Central posterior field; camera: Topcon TRC-50DX:
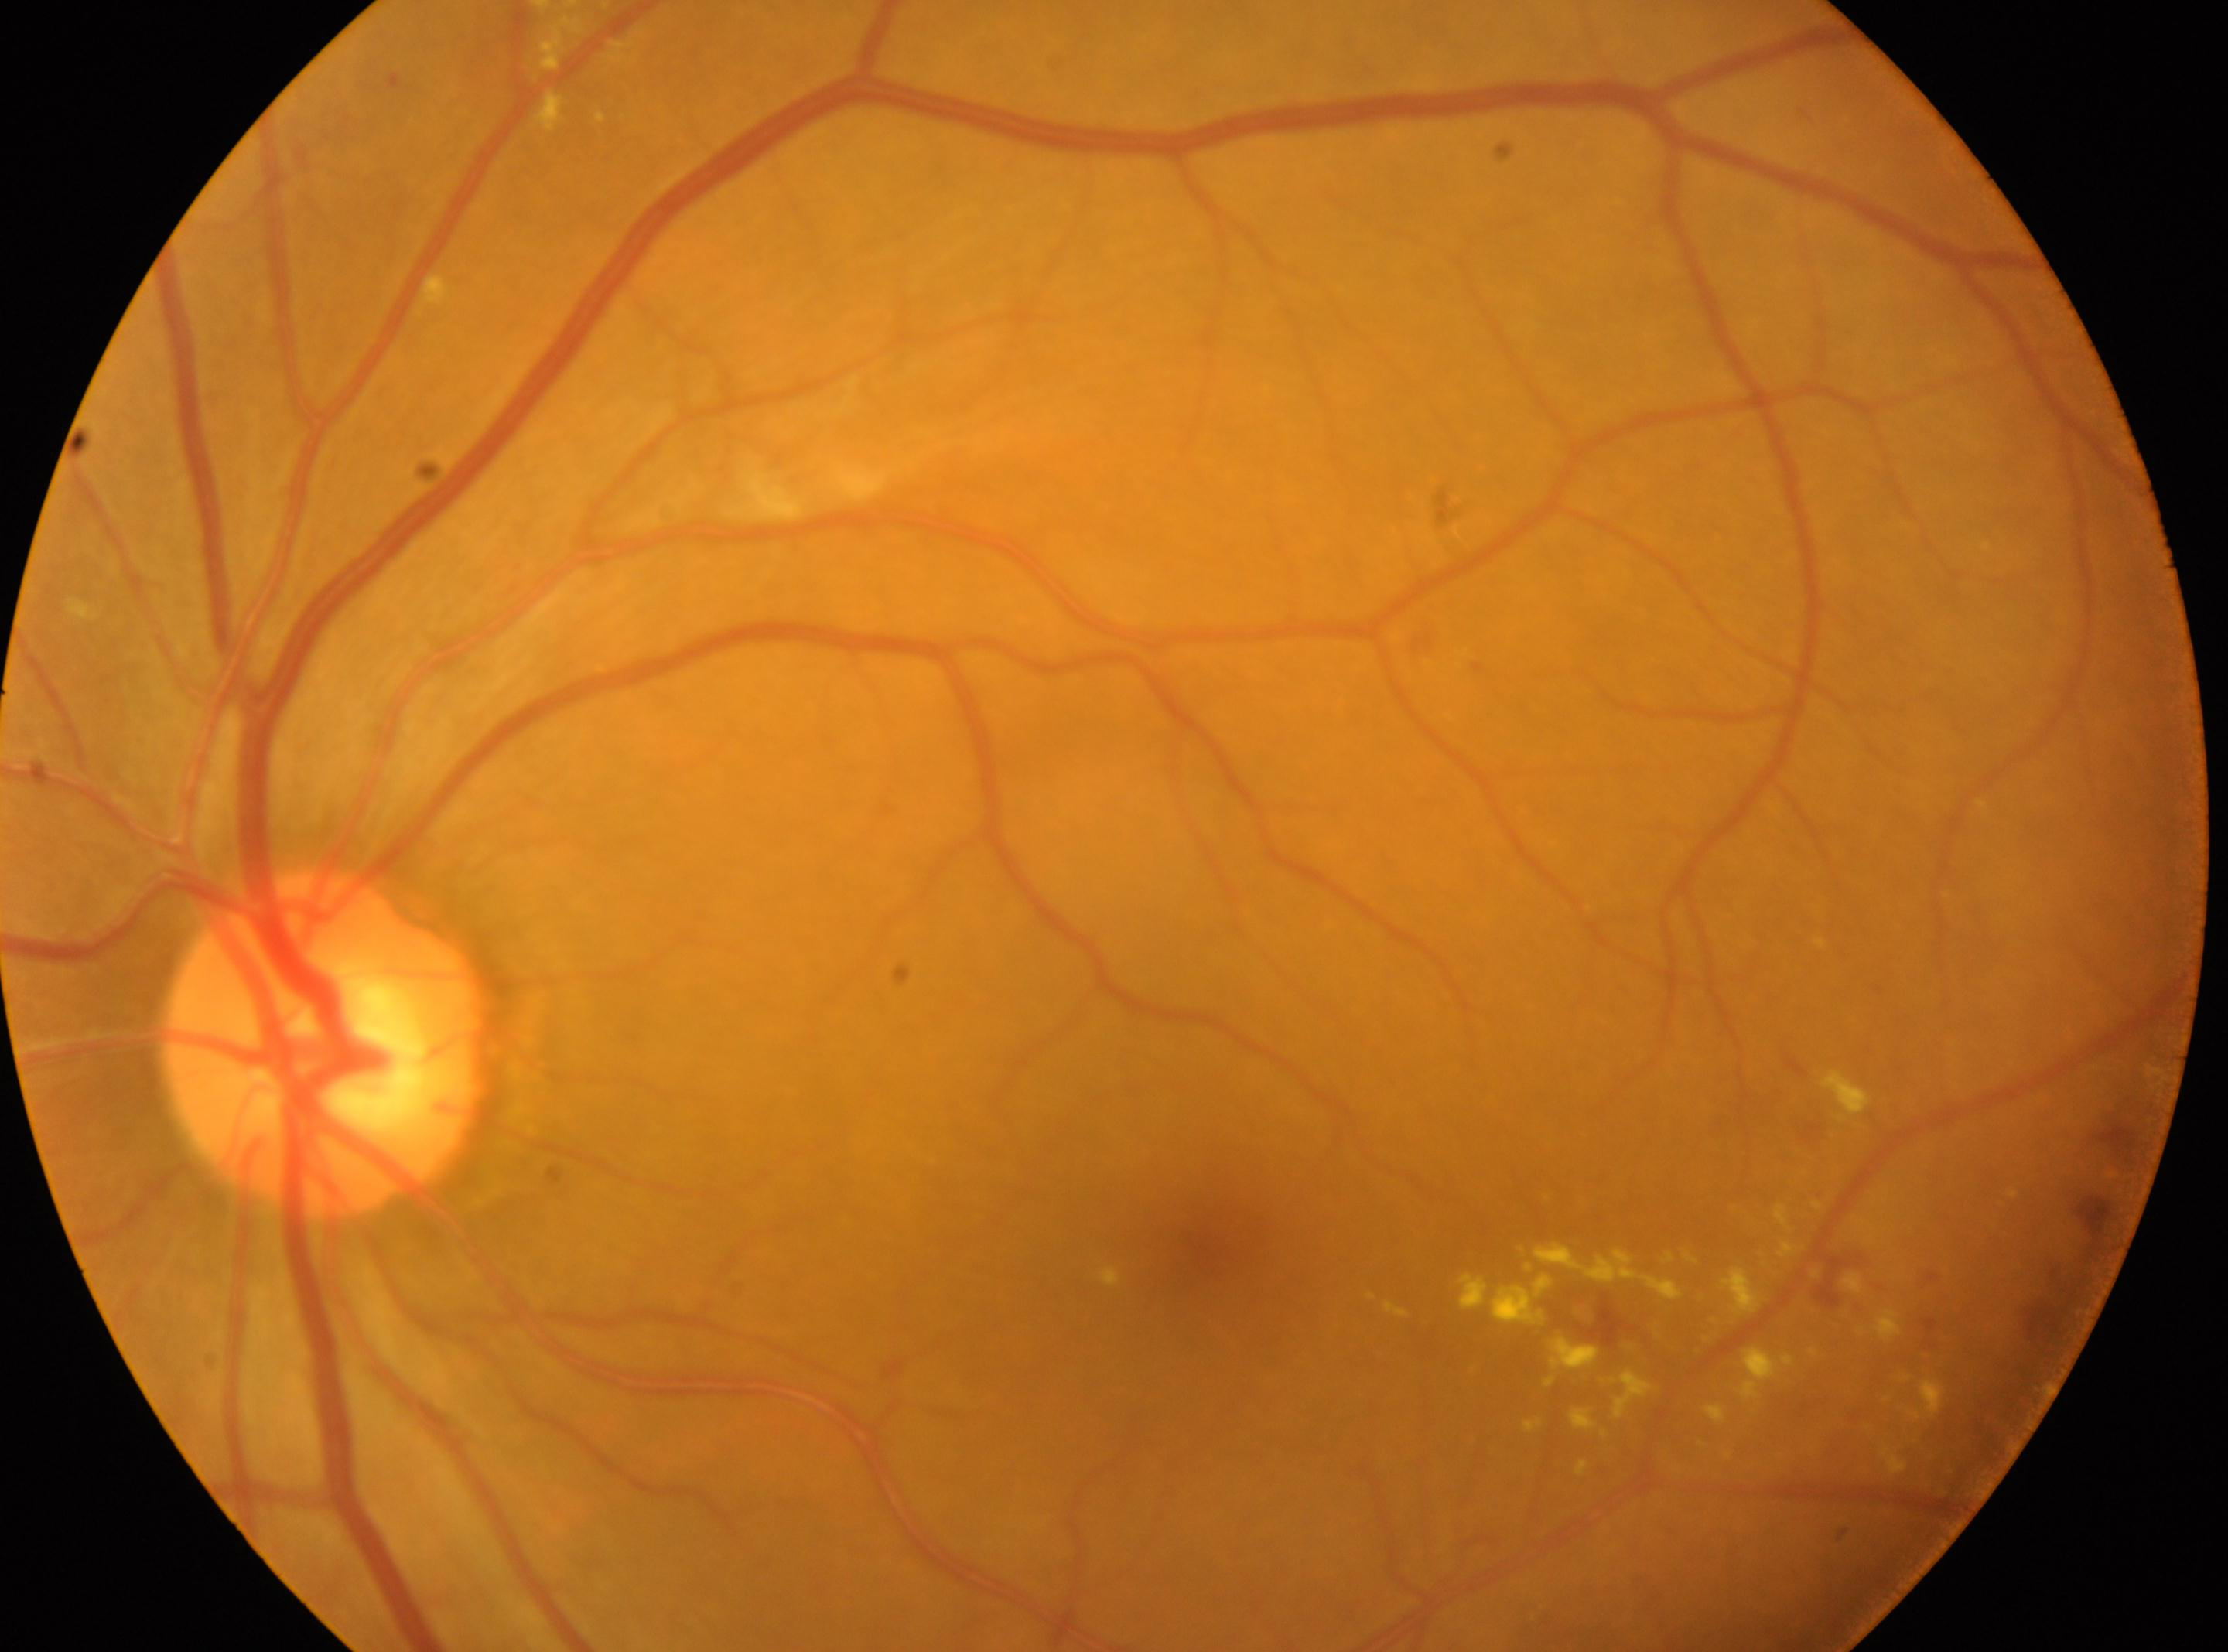
Q: Fovea center?
A: (x: 1198, y: 1253)
Q: What is the DR grade?
A: 2/4
Q: Right or left eye?
A: the left eye
Q: Where is the optic disc?
A: (x: 328, y: 1043)